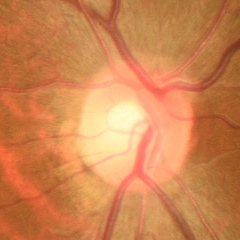

Diagnosis: no glaucomatous changes.